Retinal fundus photograph.
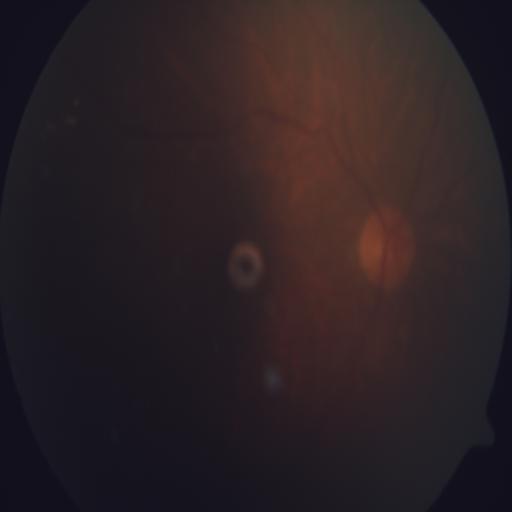
There is evidence of tessellation (TSLN).